1932x1932; 45° field of view; color fundus photograph.
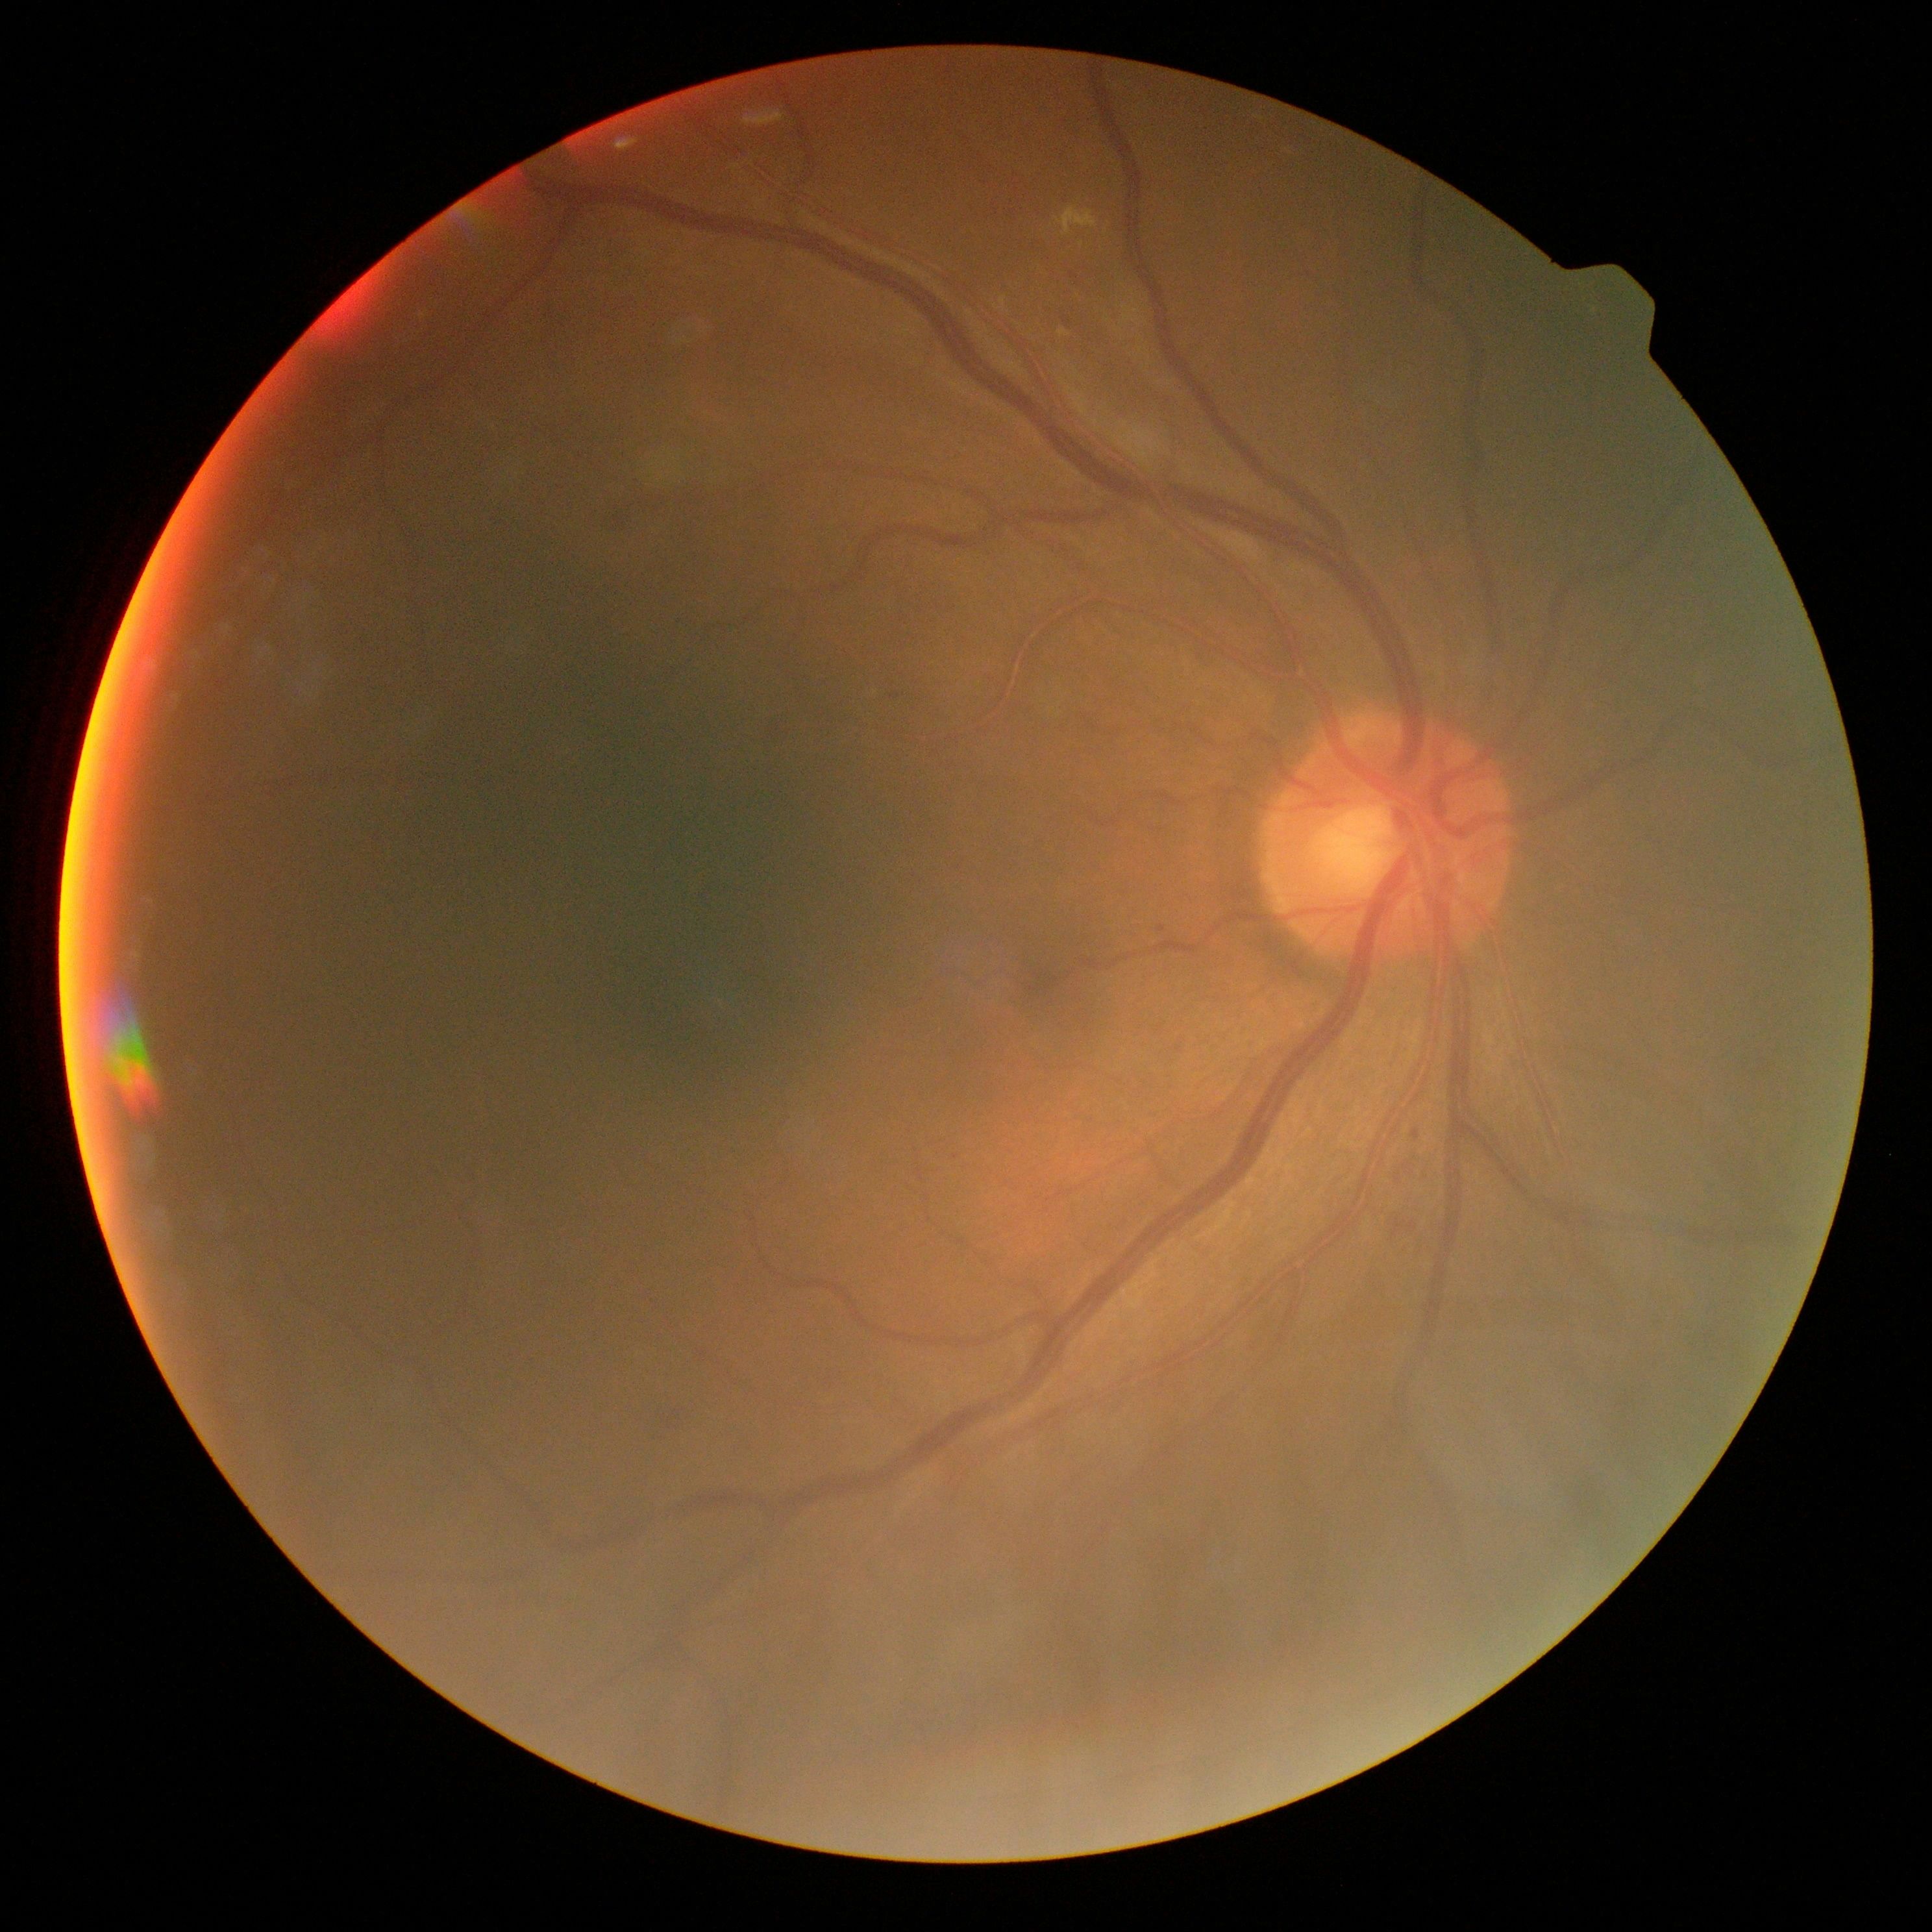

Annotations:
• retinopathy — grade 2